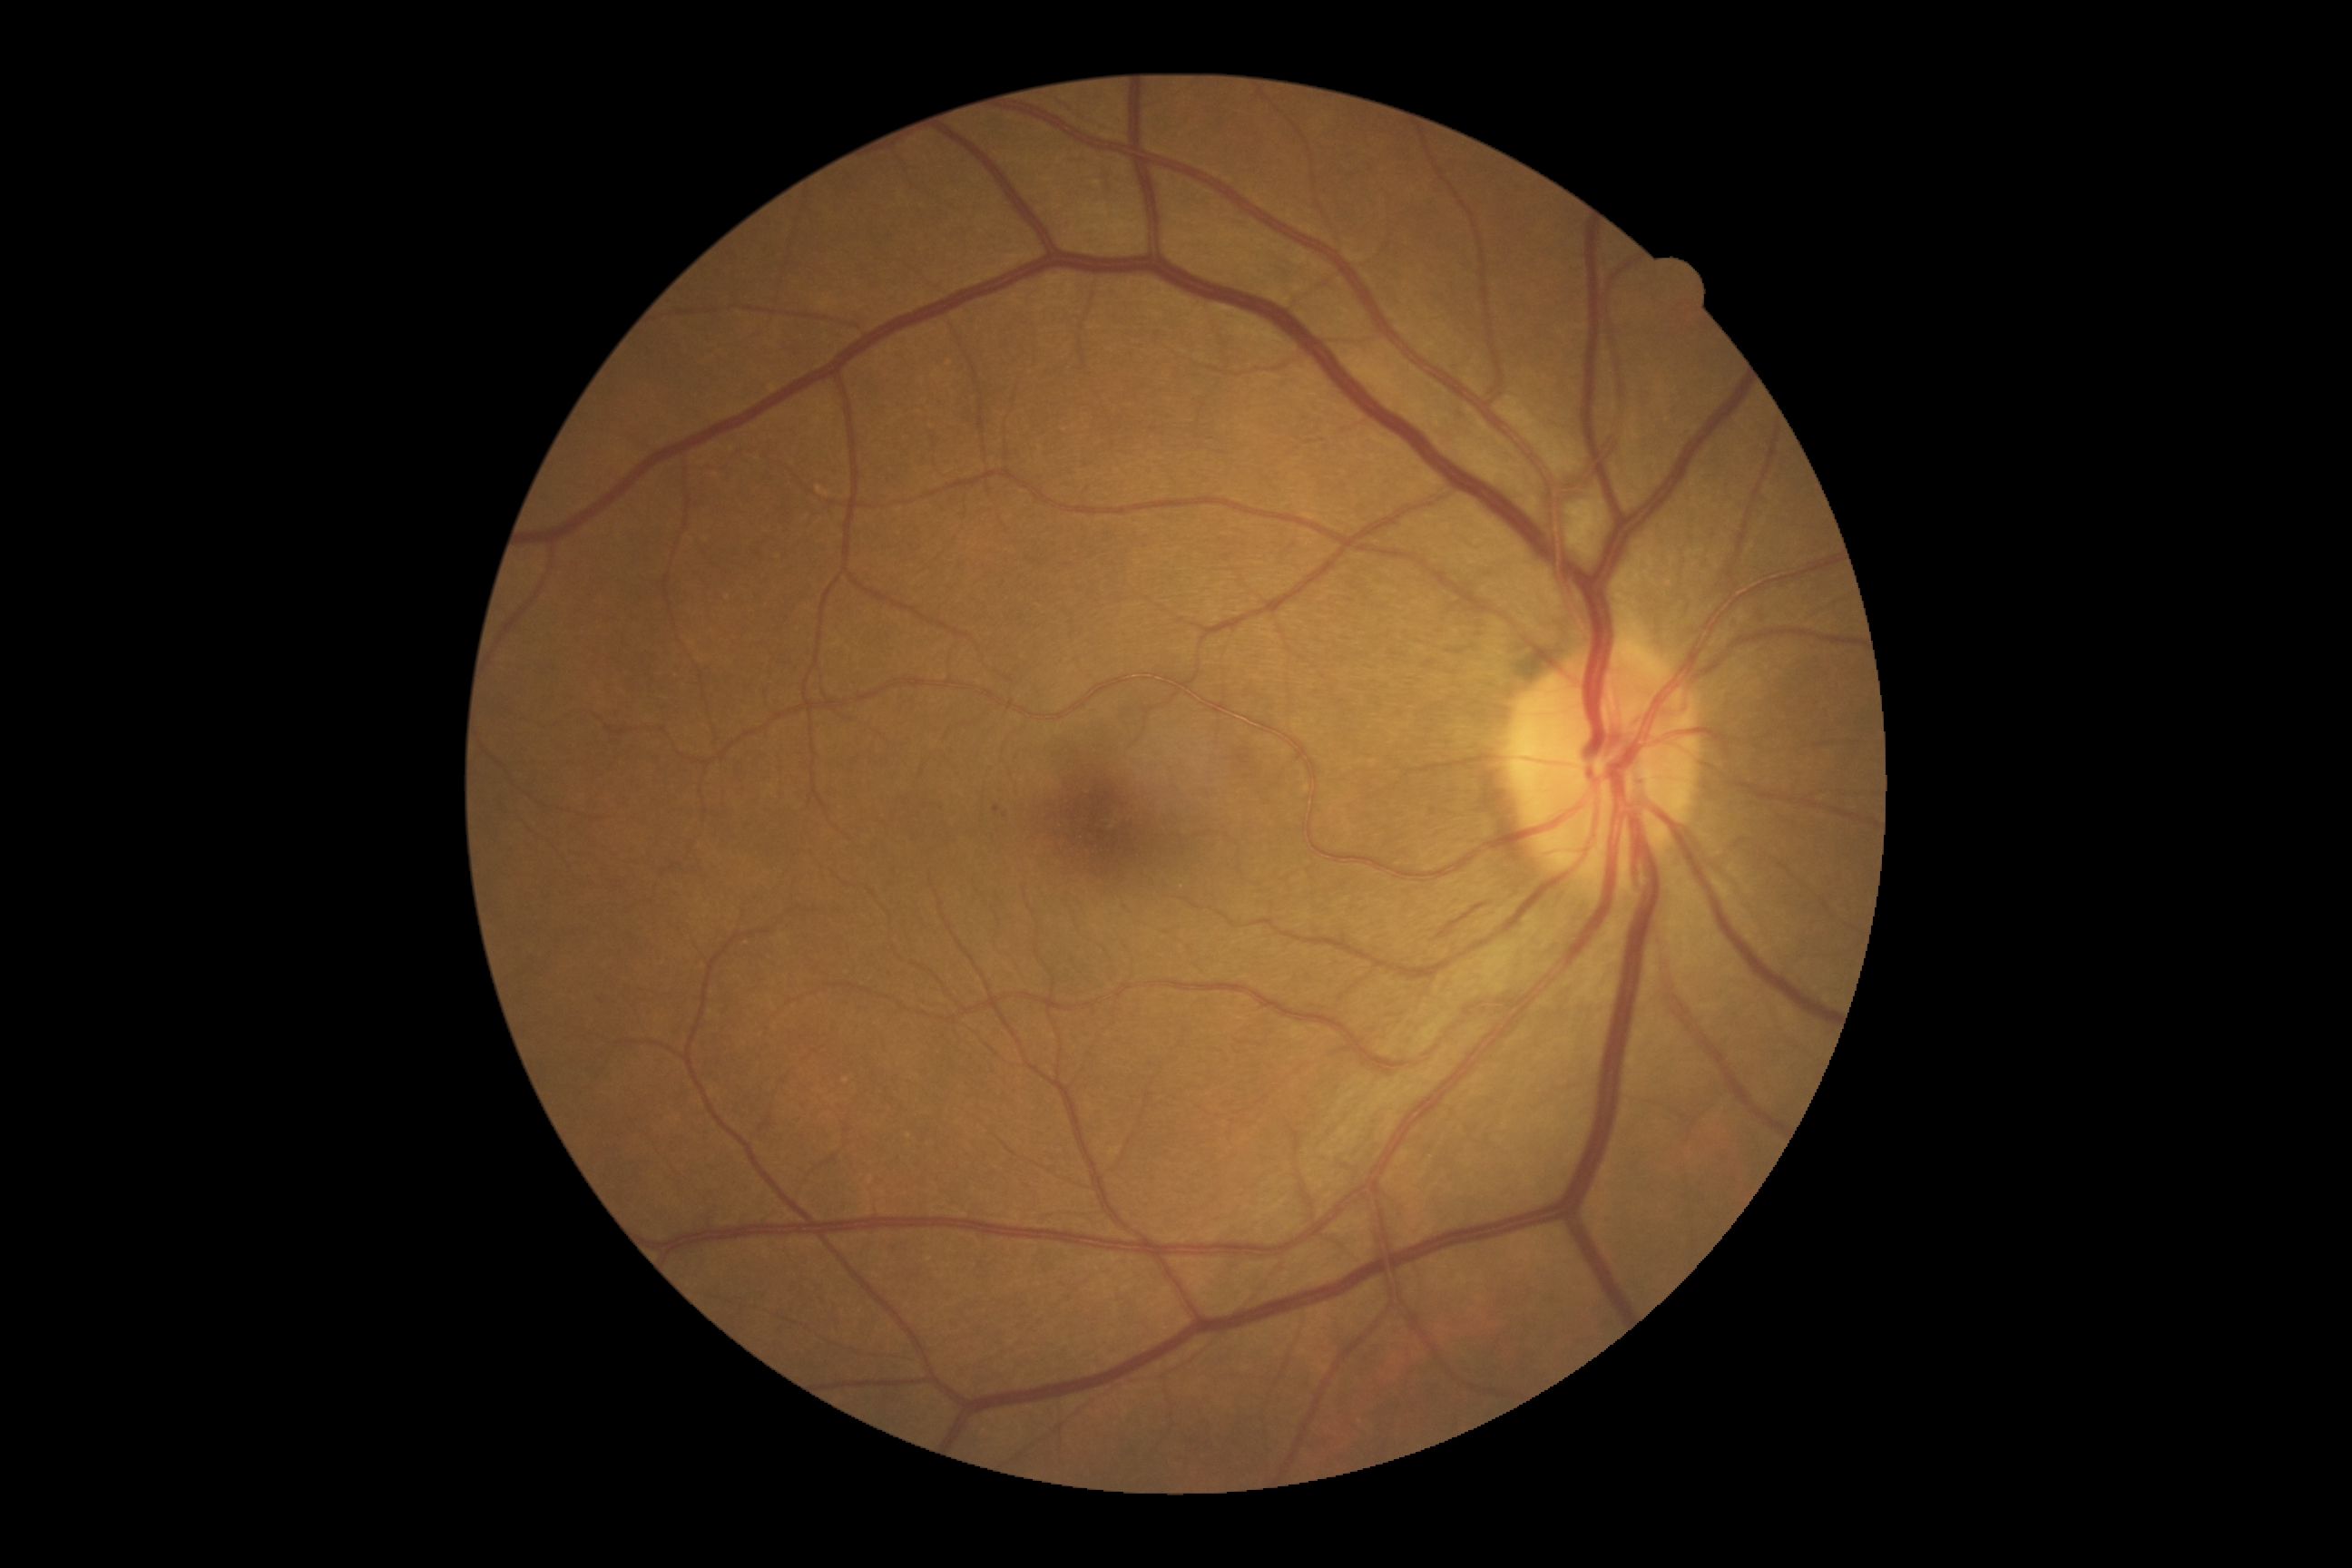

DR grade is 2 (moderate NPDR).